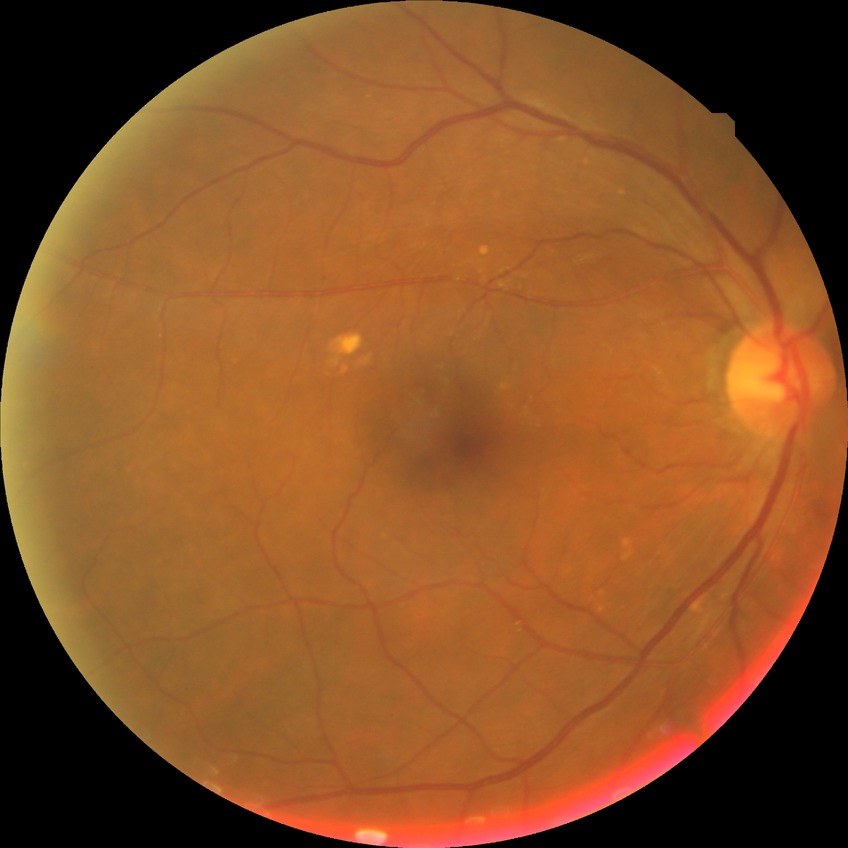

Diabetic retinopathy (DR) is no diabetic retinopathy (NDR).